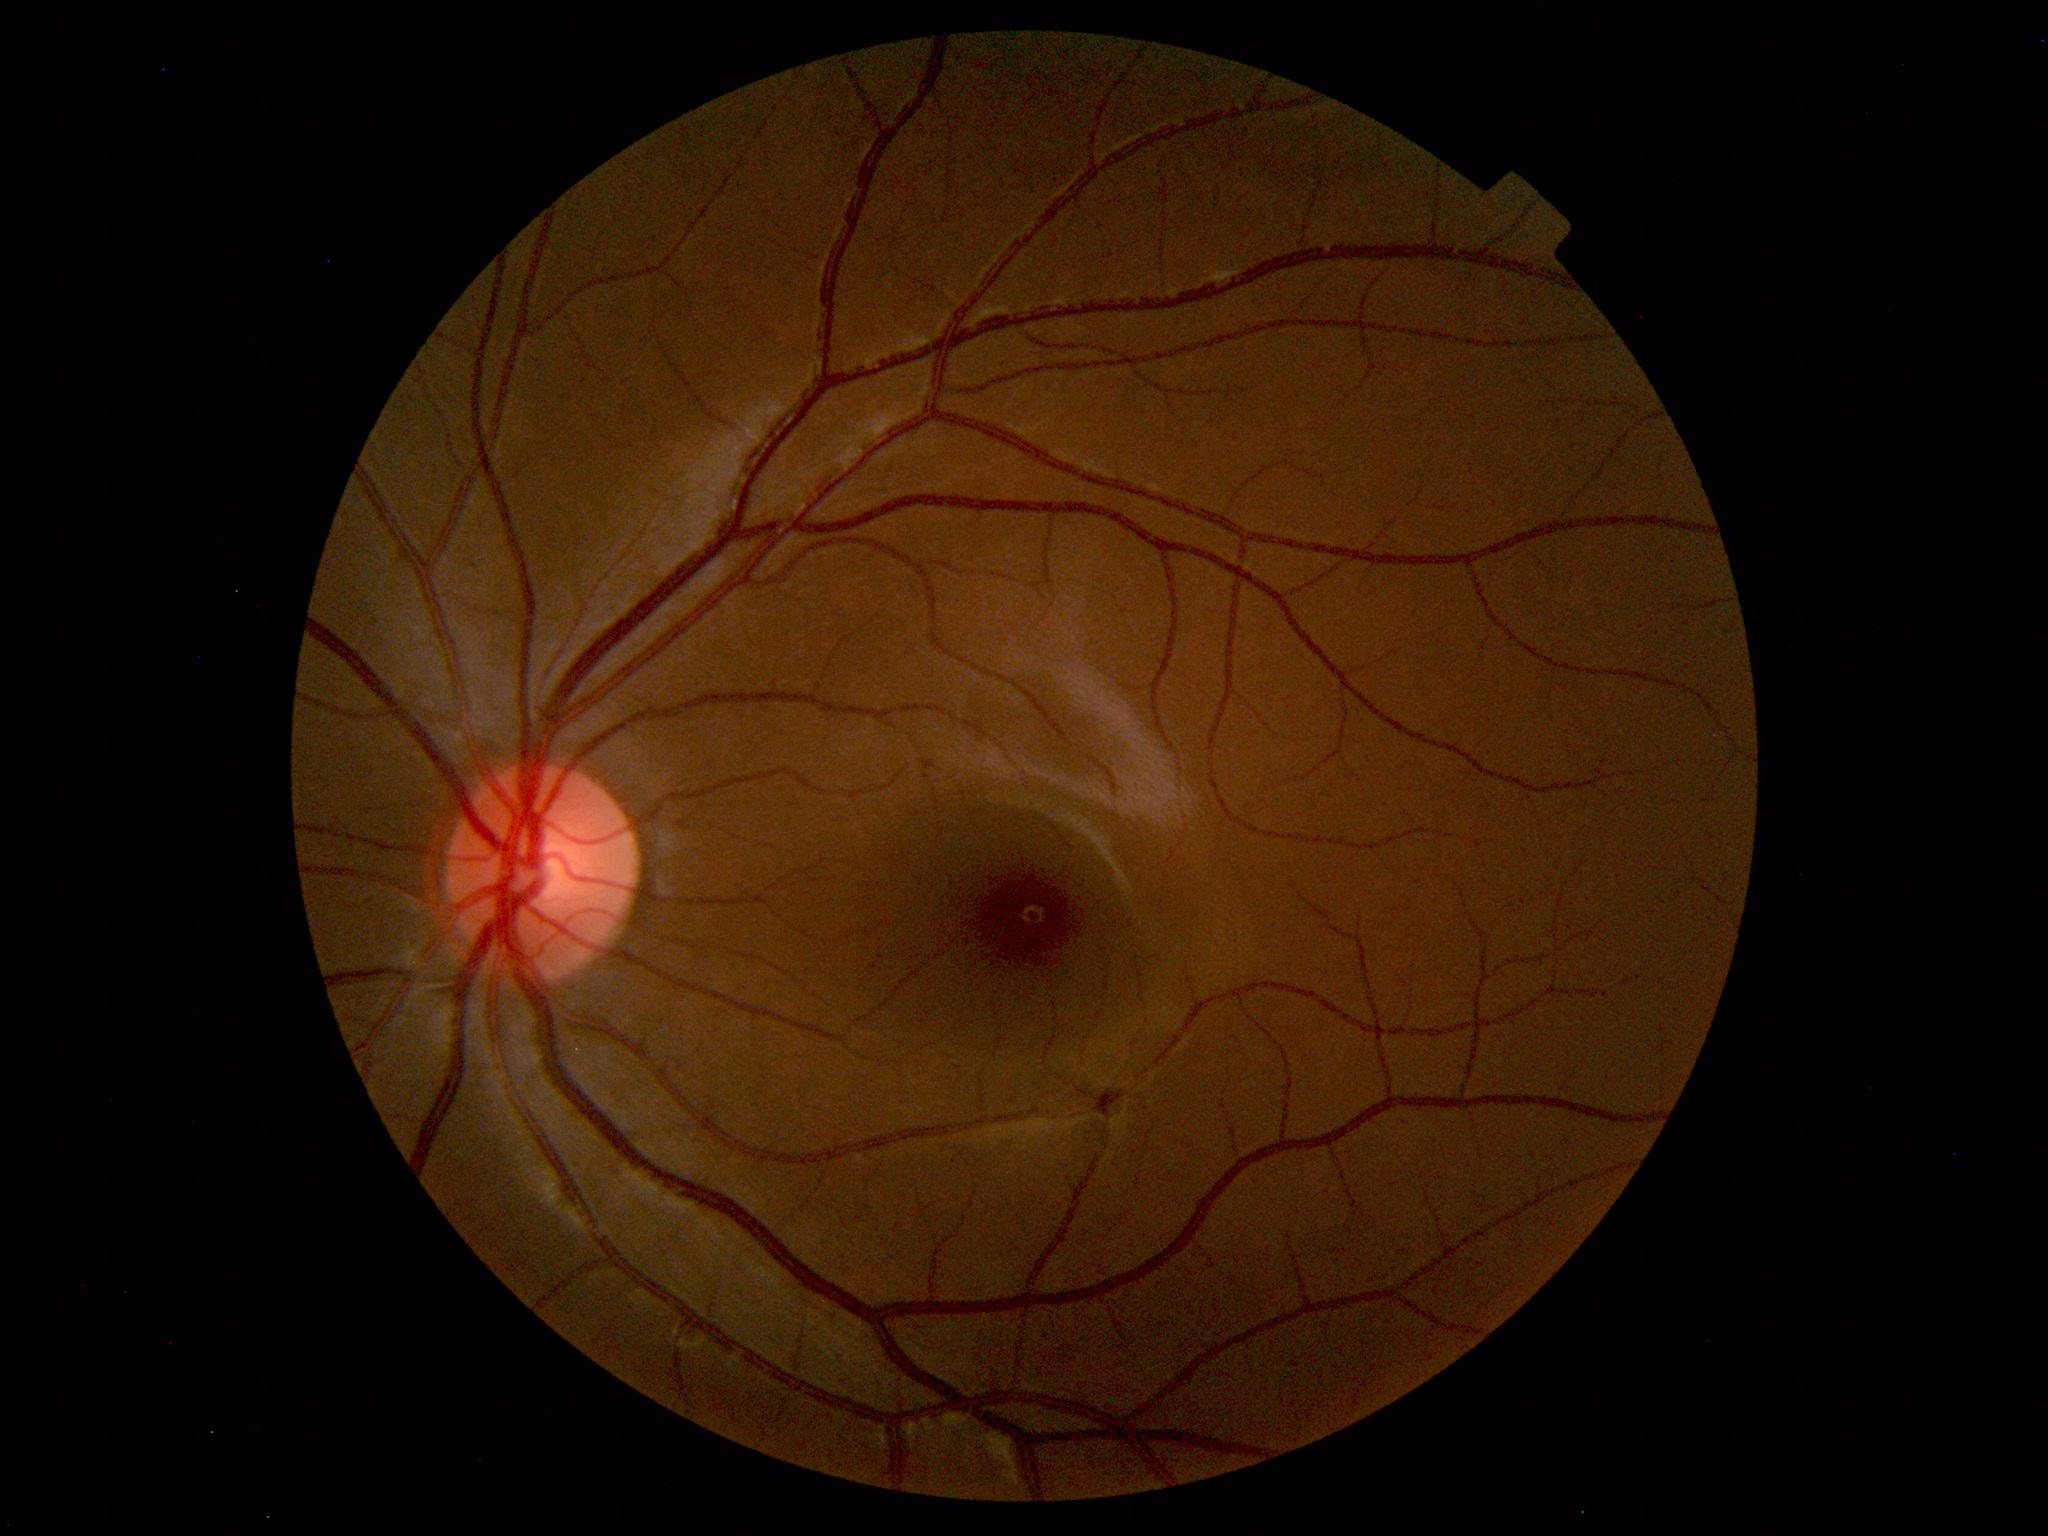

Impression: normal fundus.